Wide-field contact fundus photograph of an infant.
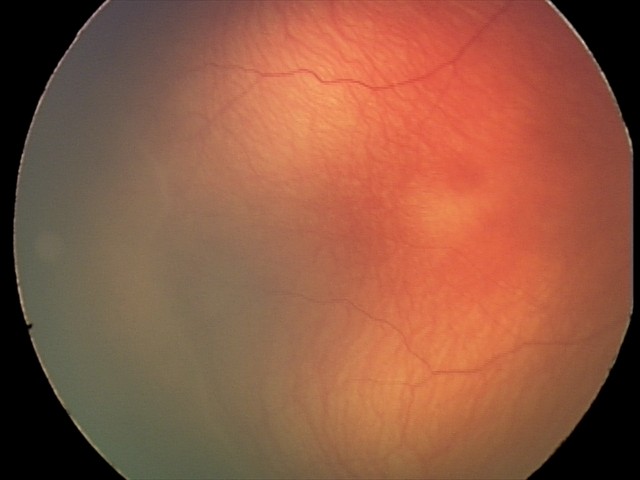
Screening examination consistent with retinopathy of prematurity (ROP) stage 2.